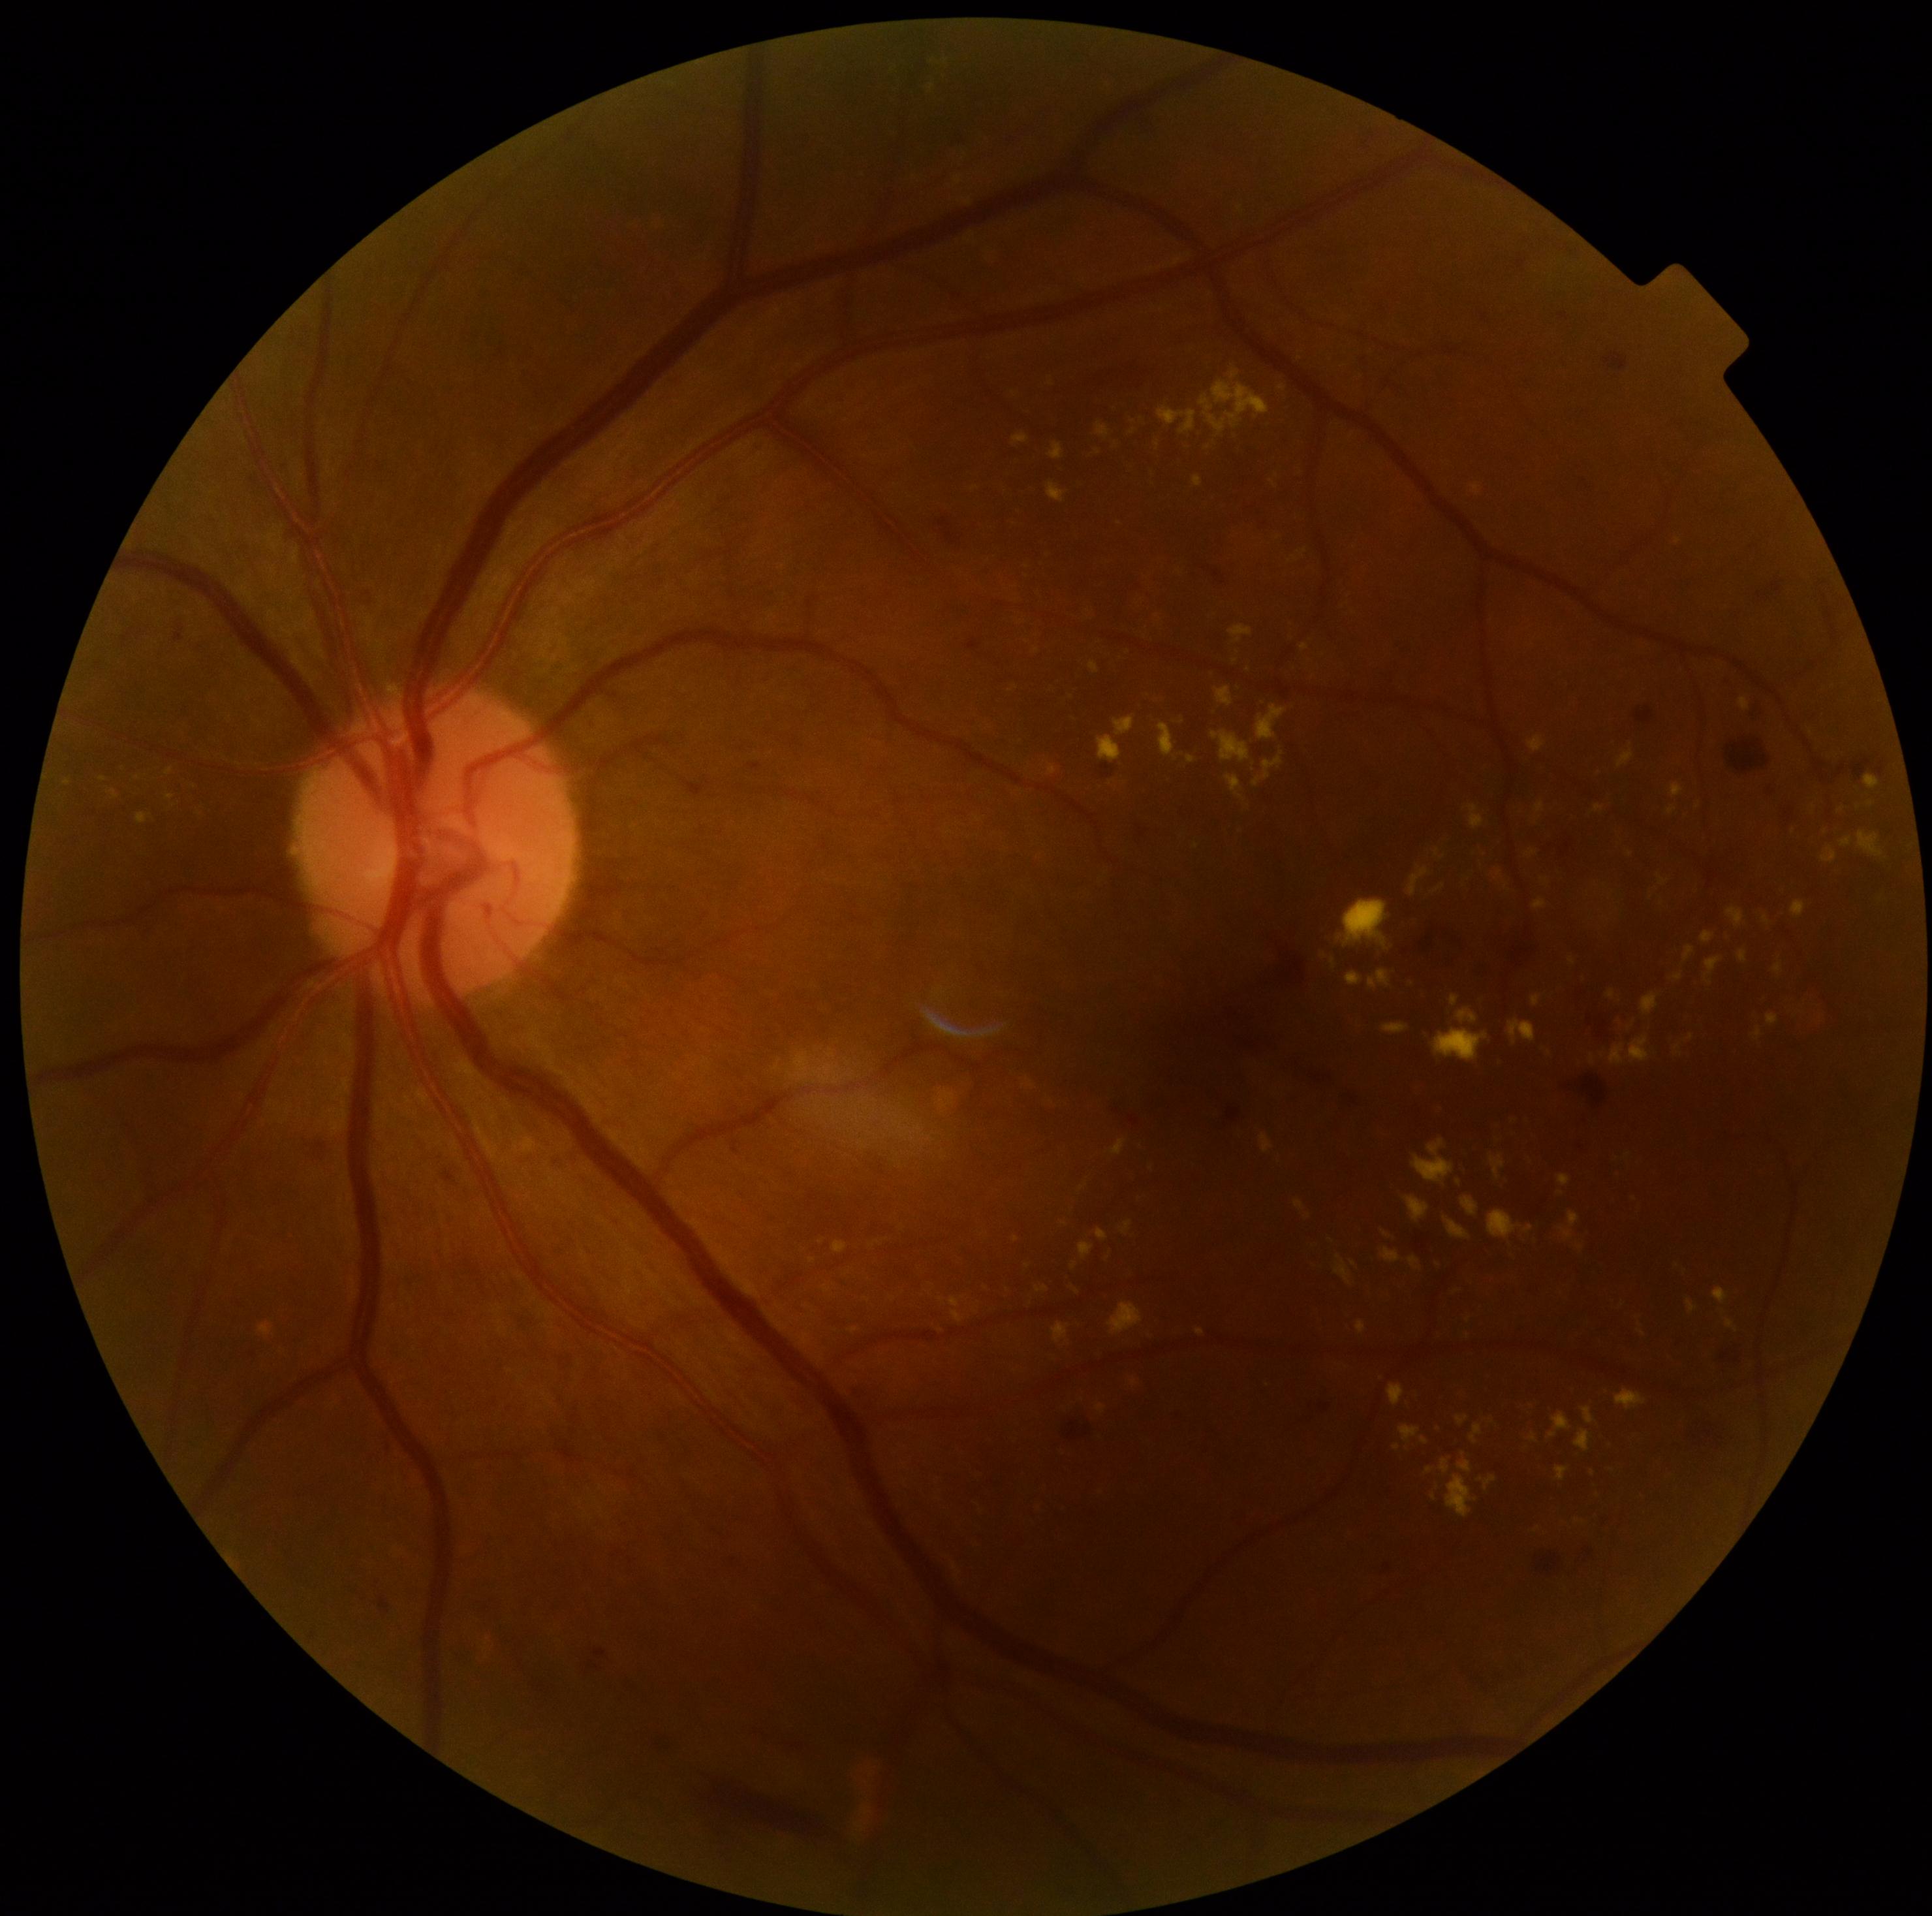 Retinopathy: moderate non-proliferative diabetic retinopathy (grade 2) — more than just microaneurysms but less than severe NPDR
A subset of detected lesions:
* hard exudates (continued): bbox=(1673, 973, 1683, 982); bbox=(1382, 1024, 1409, 1034); bbox=(1775, 964, 1783, 974); bbox=(777, 1306, 785, 1312); bbox=(1739, 699, 1751, 712); bbox=(1159, 406, 1198, 436); bbox=(1407, 1196, 1430, 1222); bbox=(1657, 876, 1669, 887); bbox=(1683, 947, 1695, 964); bbox=(1490, 1154, 1504, 1179); bbox=(1581, 1407, 1596, 1424); bbox=(1387, 1384, 1407, 1405)
* Small hard exudates near (1470,1319); (1076,1290); (1036,651); (1549,1053); (1458,1183); (1201,1332)